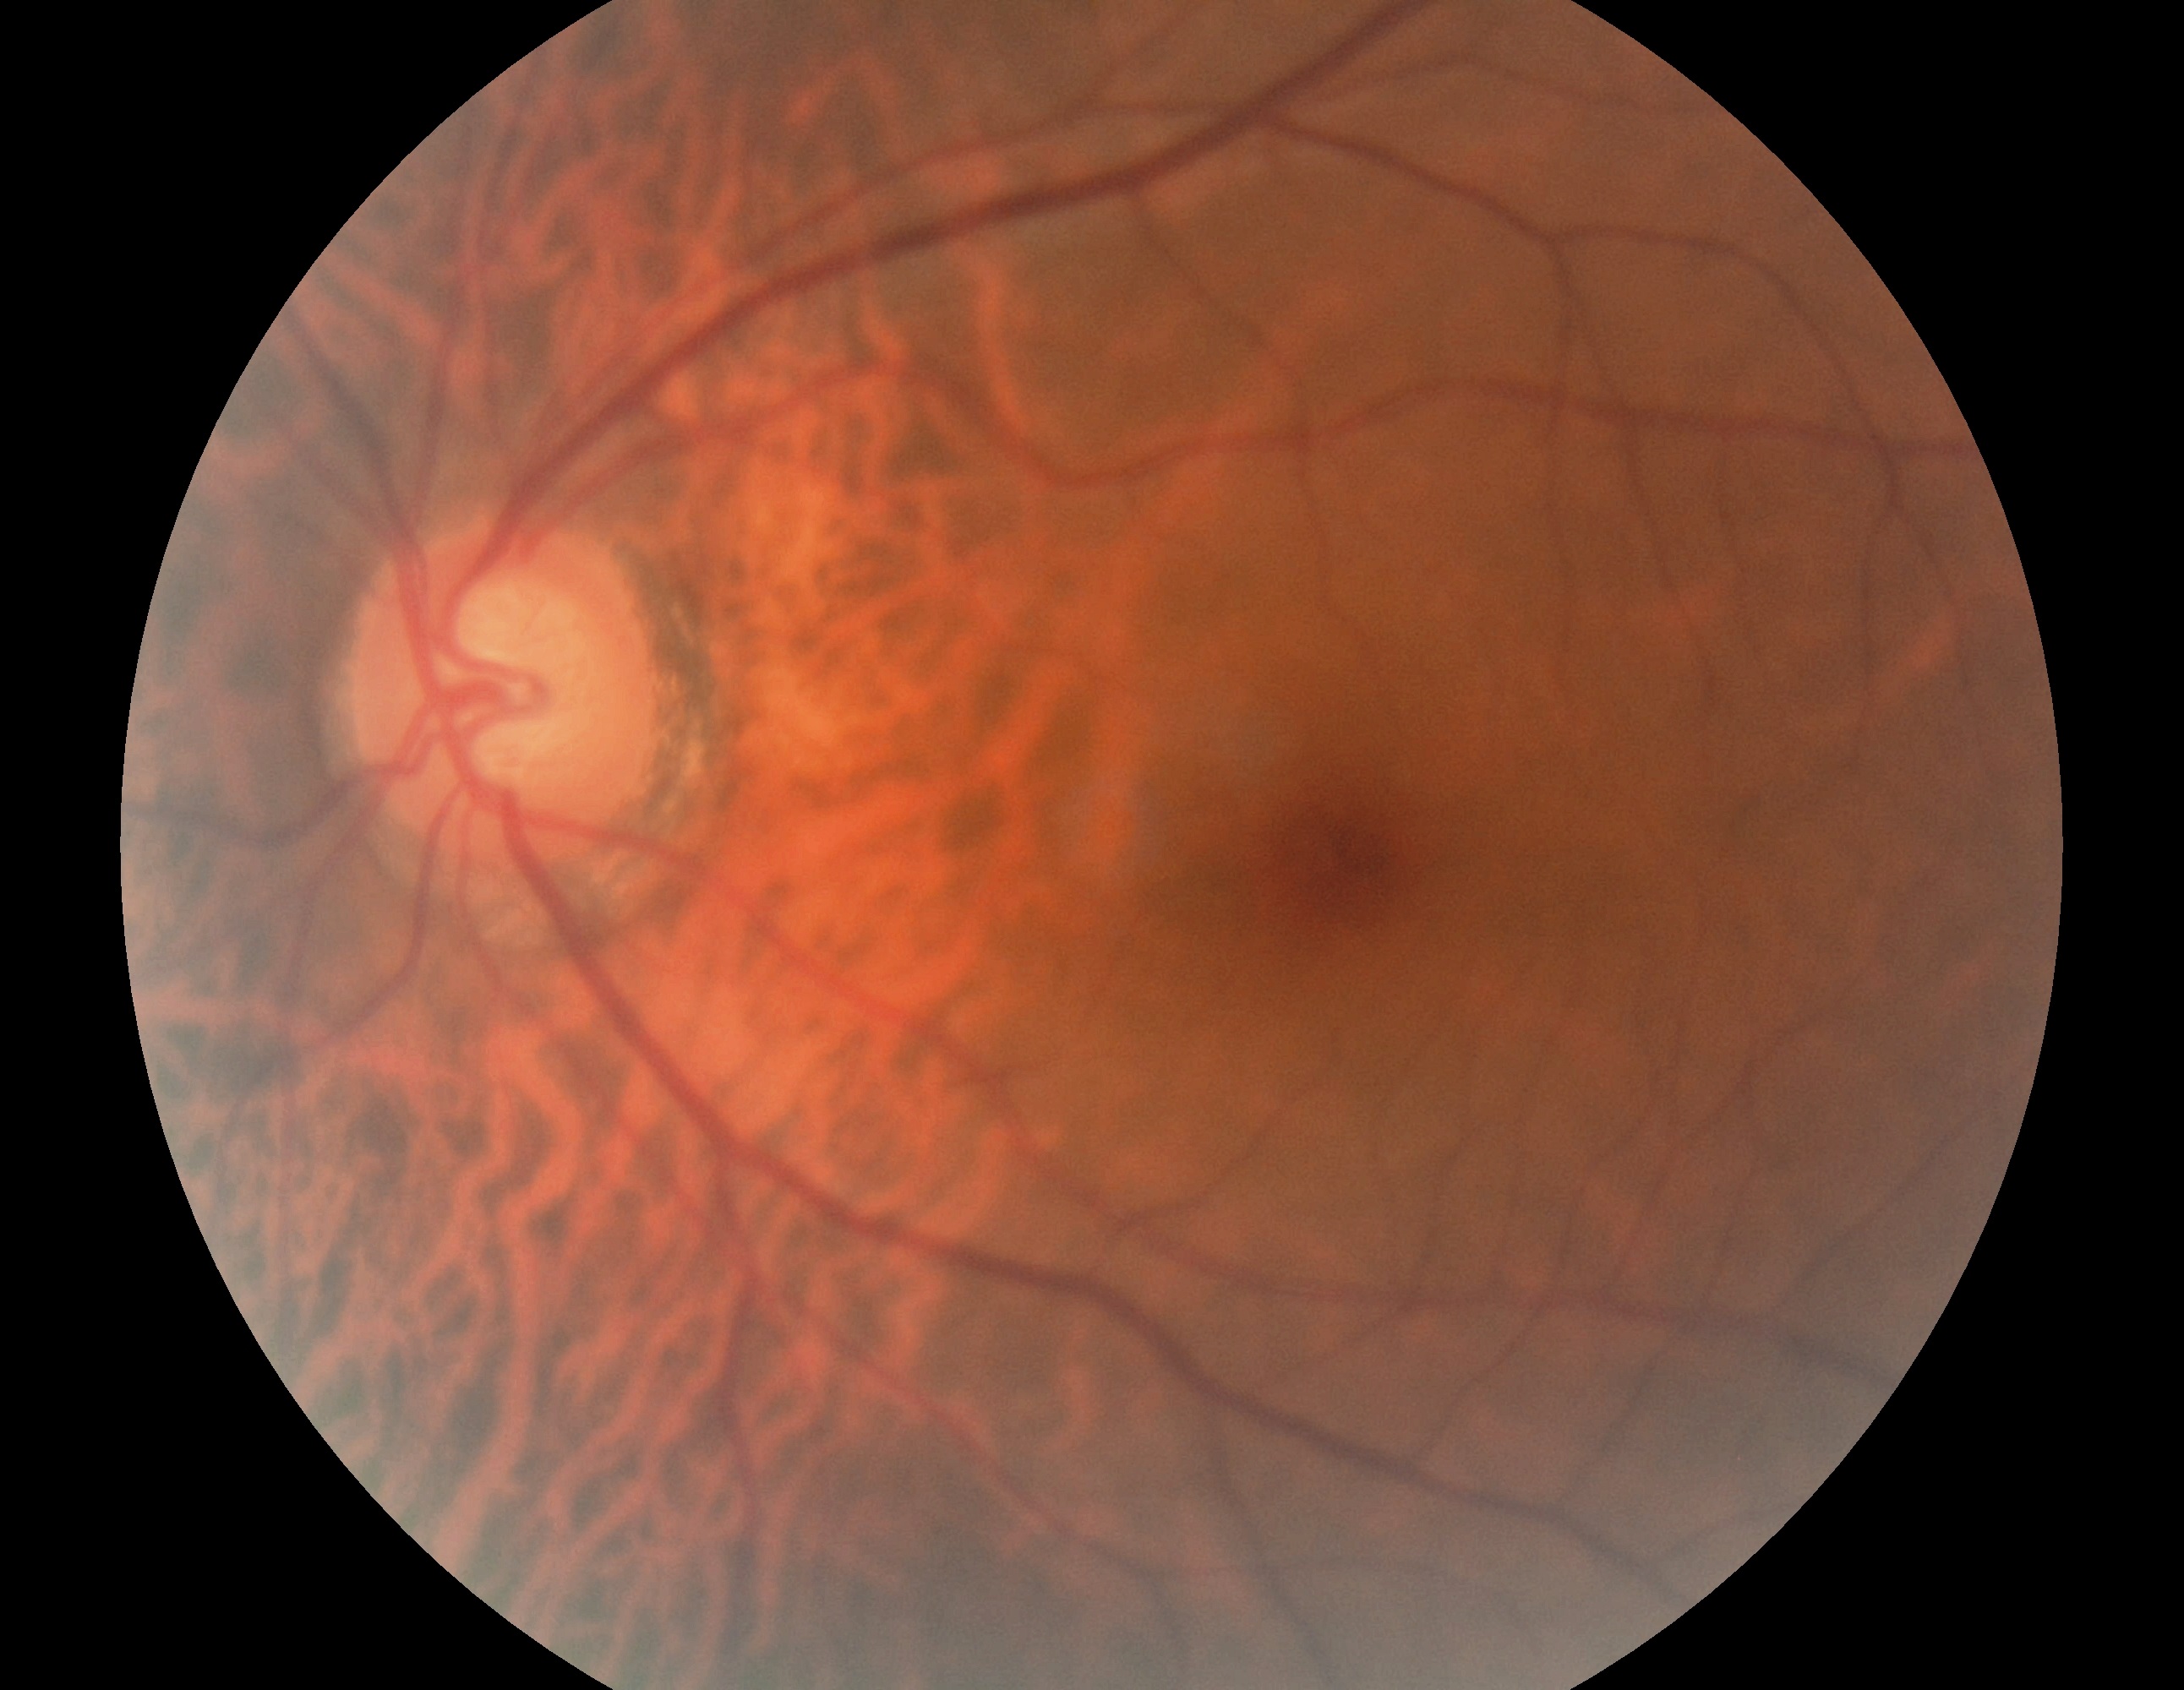 retinopathy: 0/4.